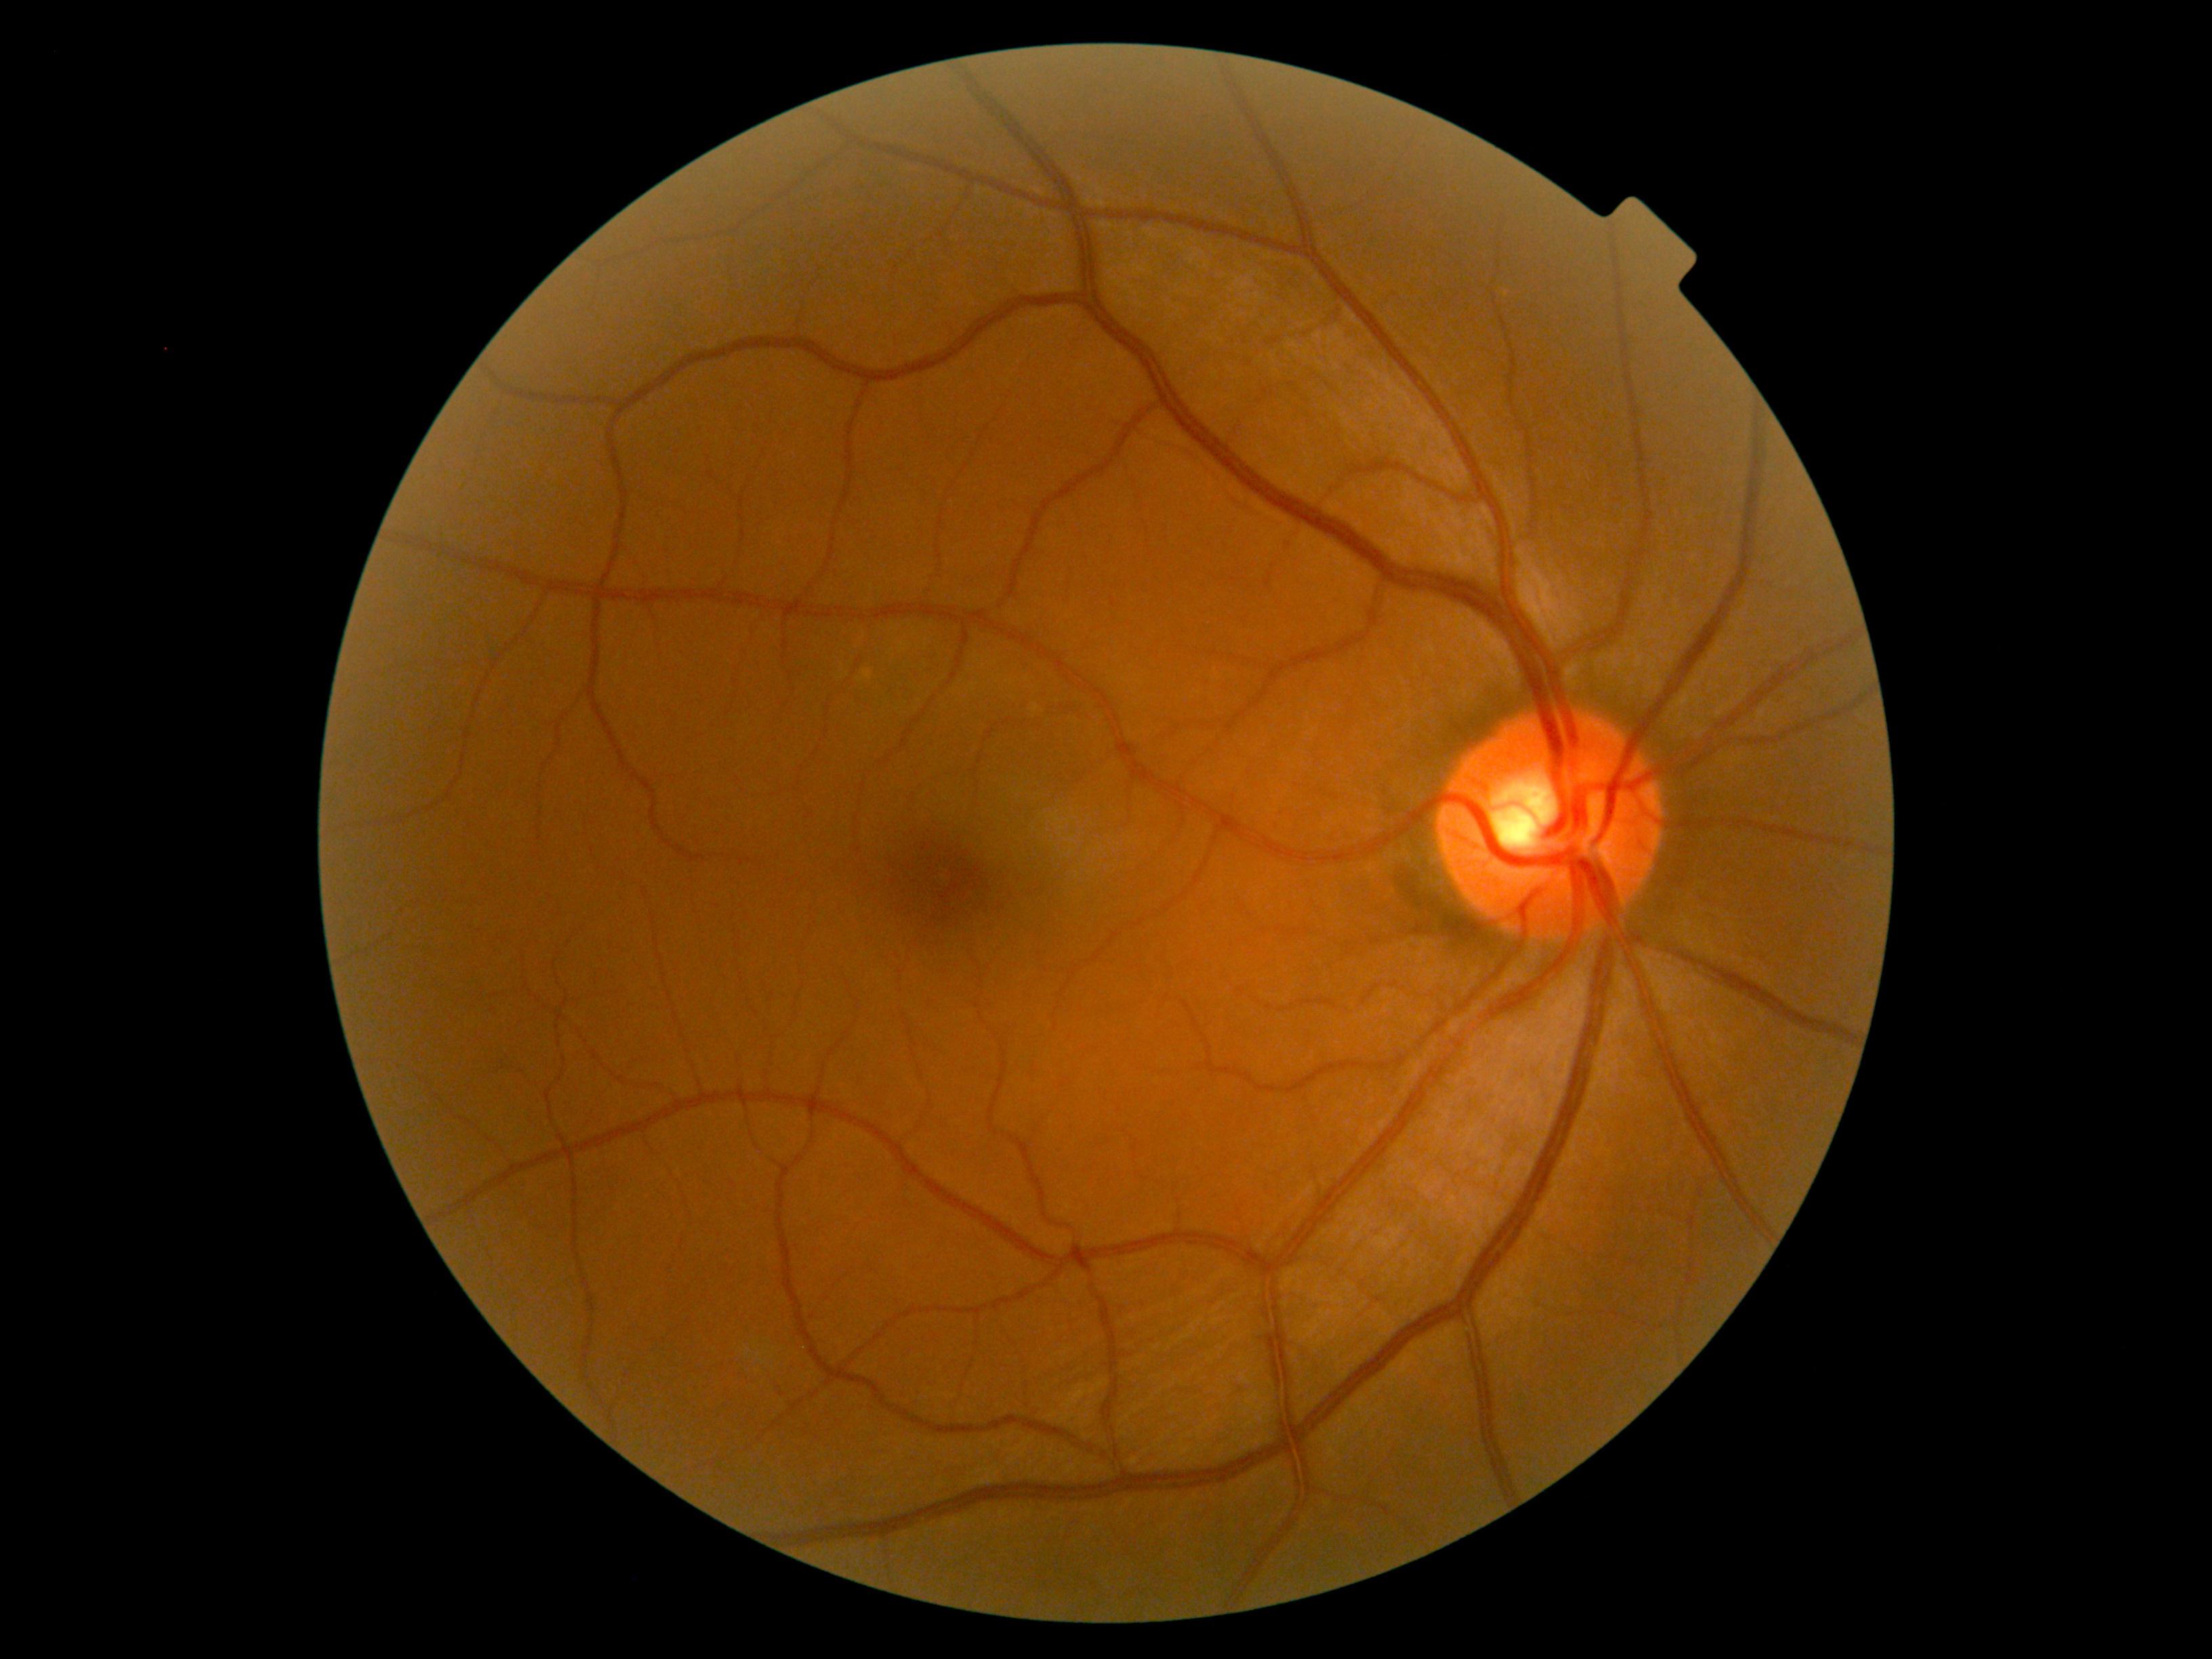

Diabetic retinopathy (DR) is no apparent retinopathy (grade 0).